848 x 848 pixels. Modified Davis classification:
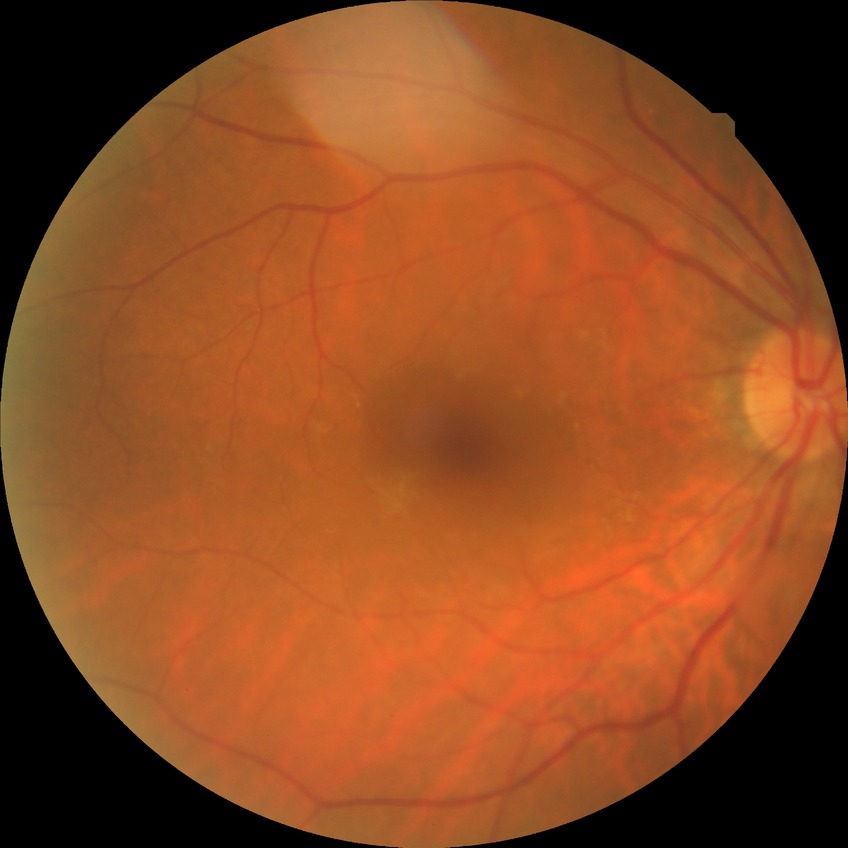
Diabetic retinopathy (DR) is no diabetic retinopathy (NDR).